Acquired on the Clarity RetCam 3; wide-field fundus image from infant ROP screening — 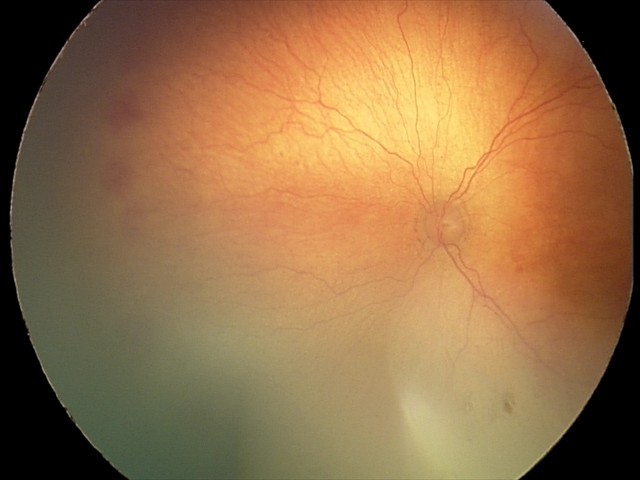 Screening diagnosis: A-ROP (aggressive ROP); plus disease.